Optic disc photograph · cropped from a 35-degree field of view — 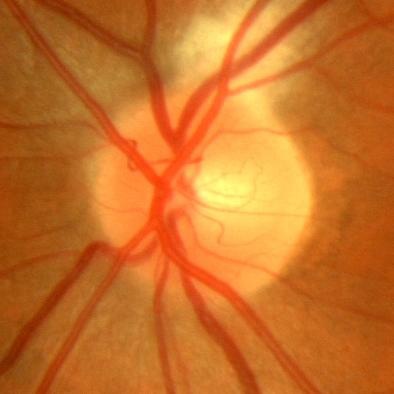
Optic disc appearance consistent with no glaucomatous optic neuropathy.